848x848px, posterior pole color fundus photograph — 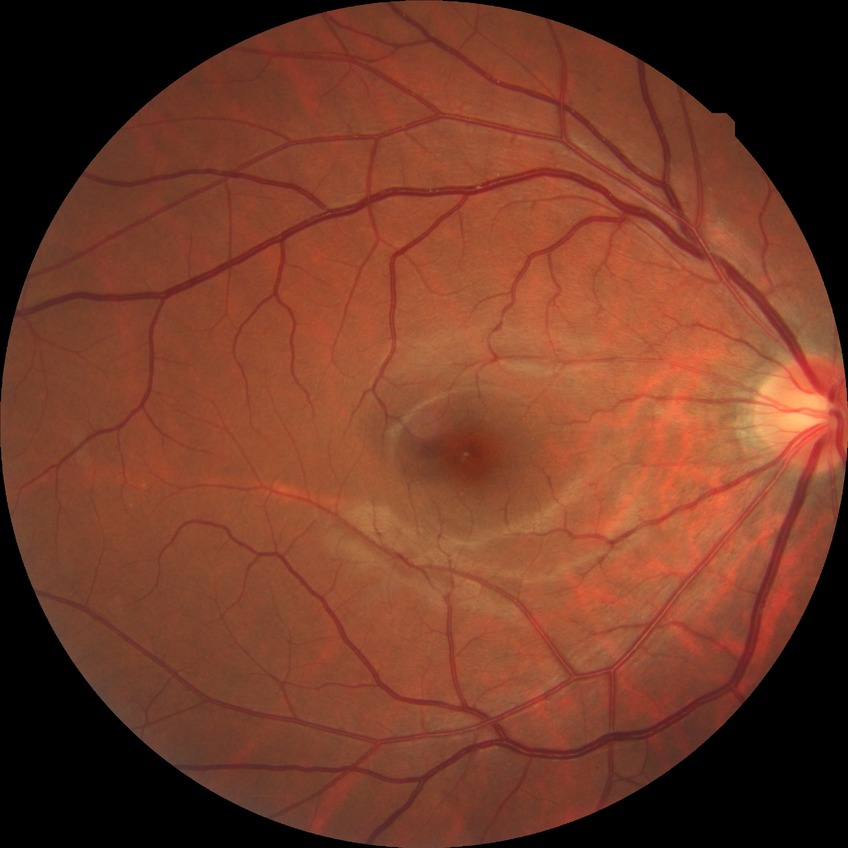
diabetic retinopathy (DR)@no diabetic retinopathy (NDR).